FOV: 45 degrees. Color fundus photograph. 2352x1568: 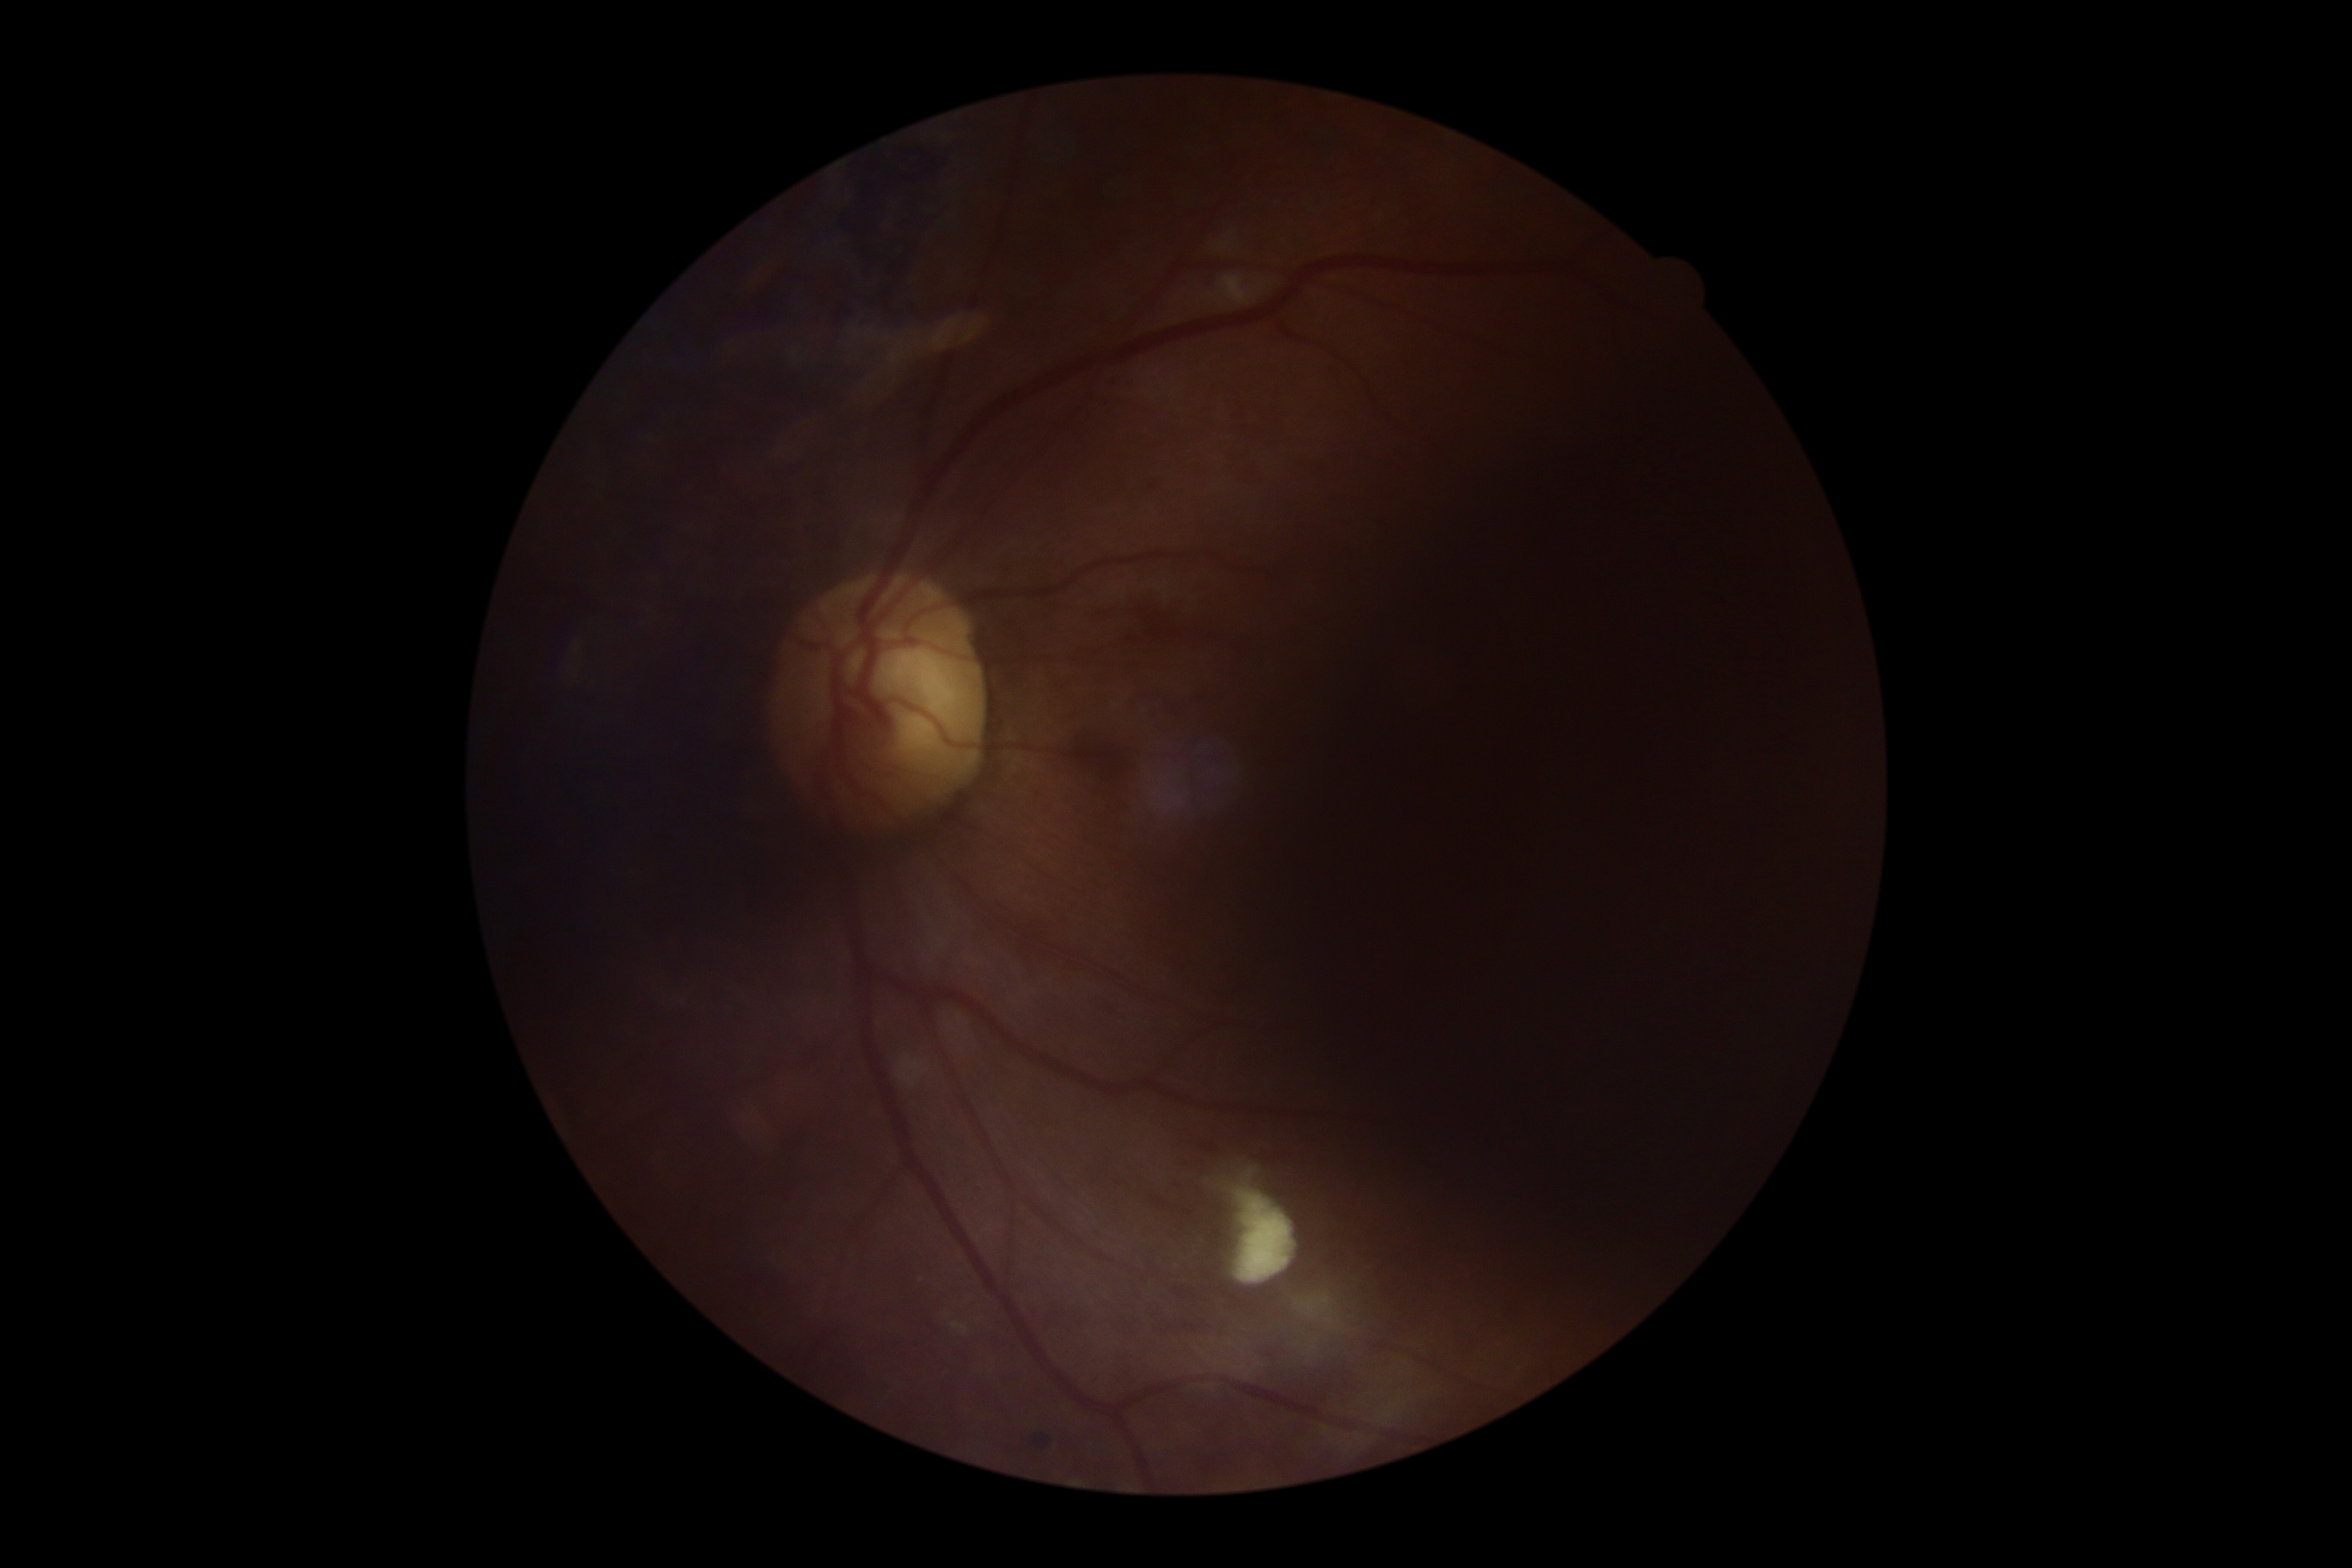 Diabetic retinopathy: grade 2 (moderate NPDR) — more than just microaneurysms but less than severe NPDR.